2212x1659 — 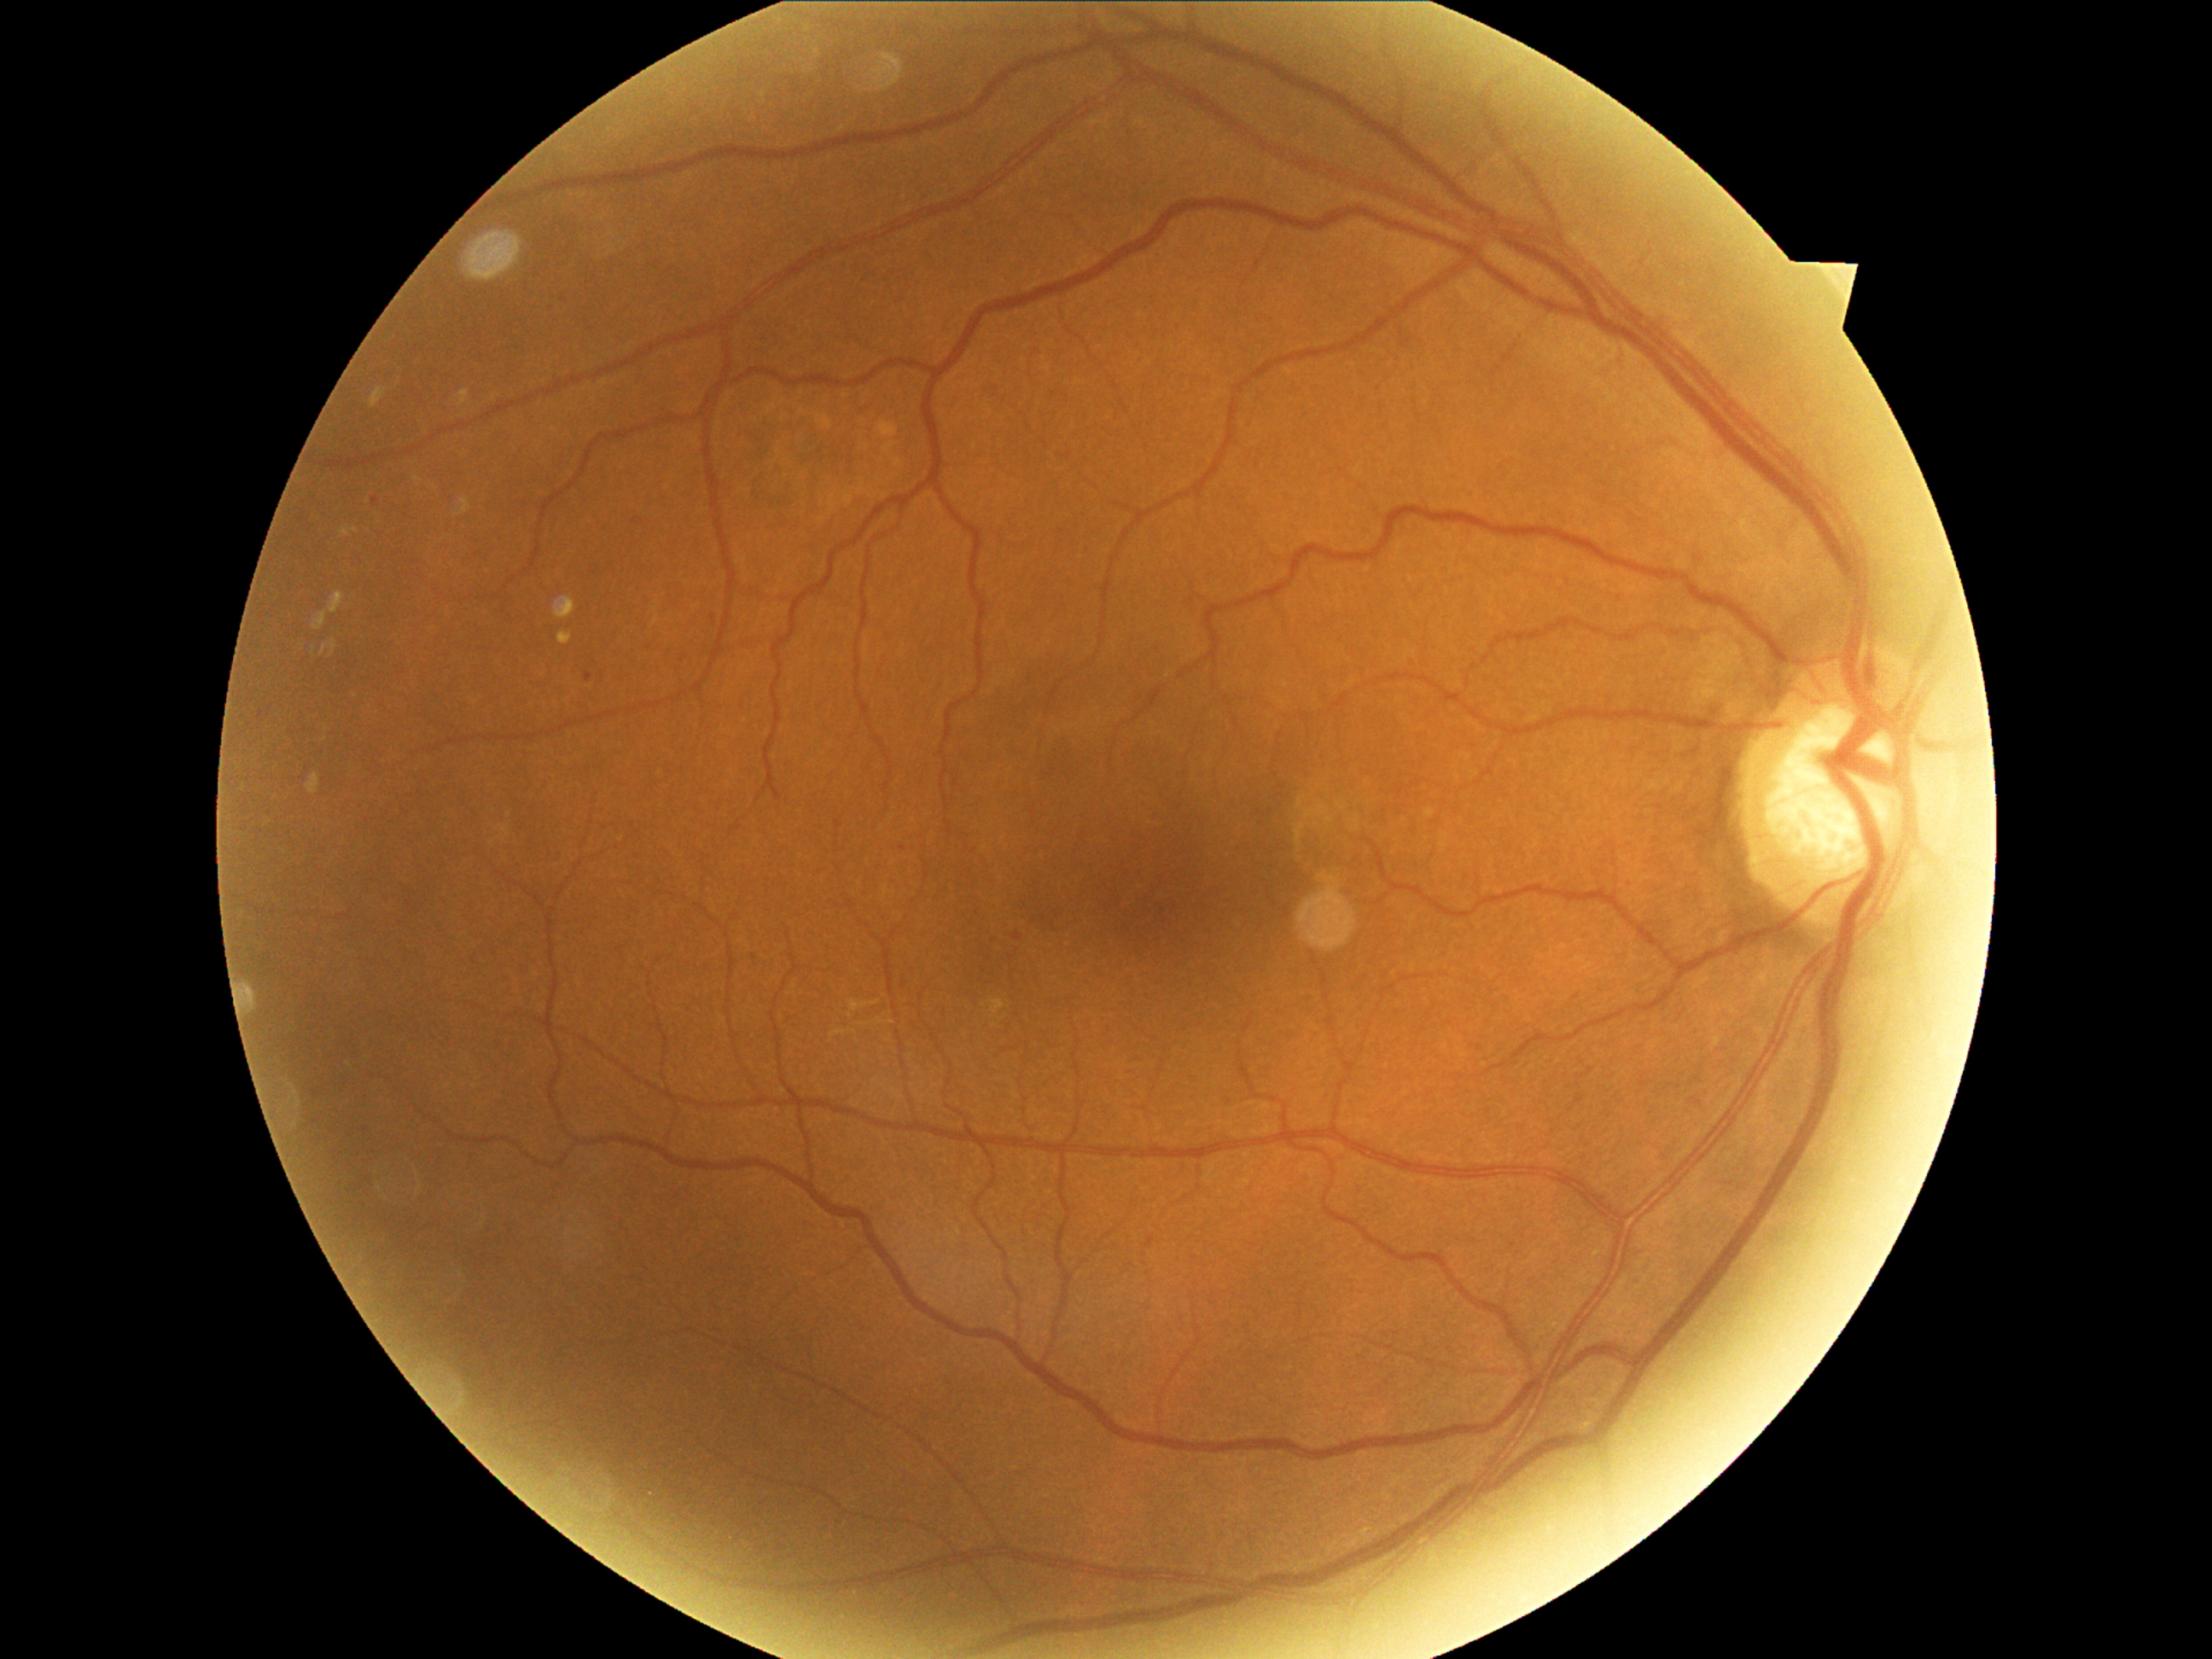
diabetic retinopathy severity = grade 1 (mild NPDR) — presence of microaneurysms only